640x480px. RetCam wide-field infant fundus image
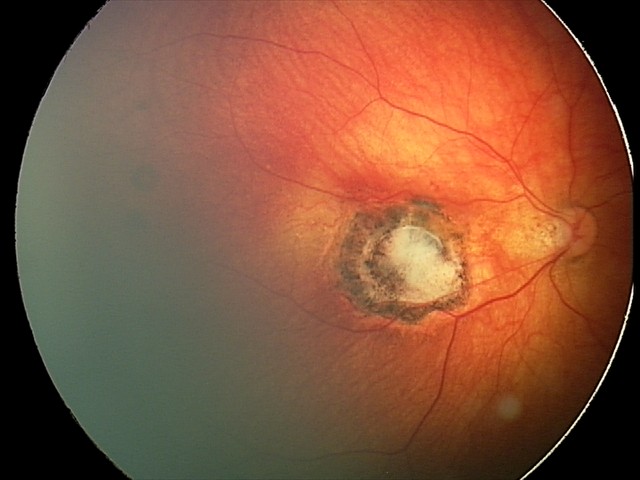 Finding = toxoplasmosis chorioretinitis